Davis DR grading
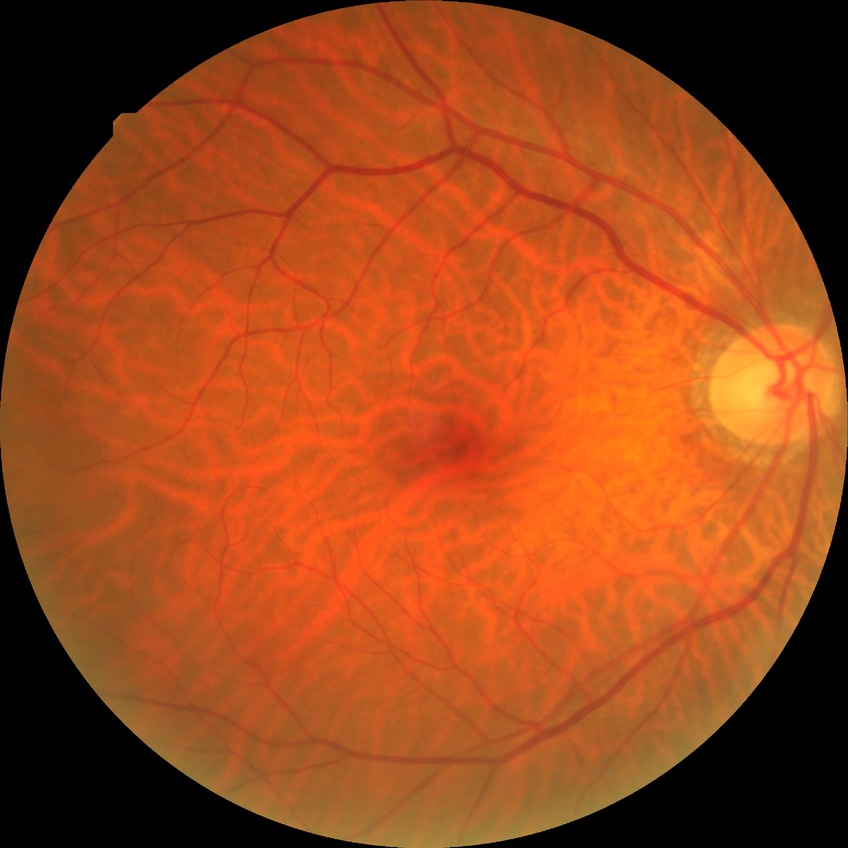

Diabetic retinopathy (DR) is no diabetic retinopathy (NDR).